Retinal fundus photograph. 45° field of view
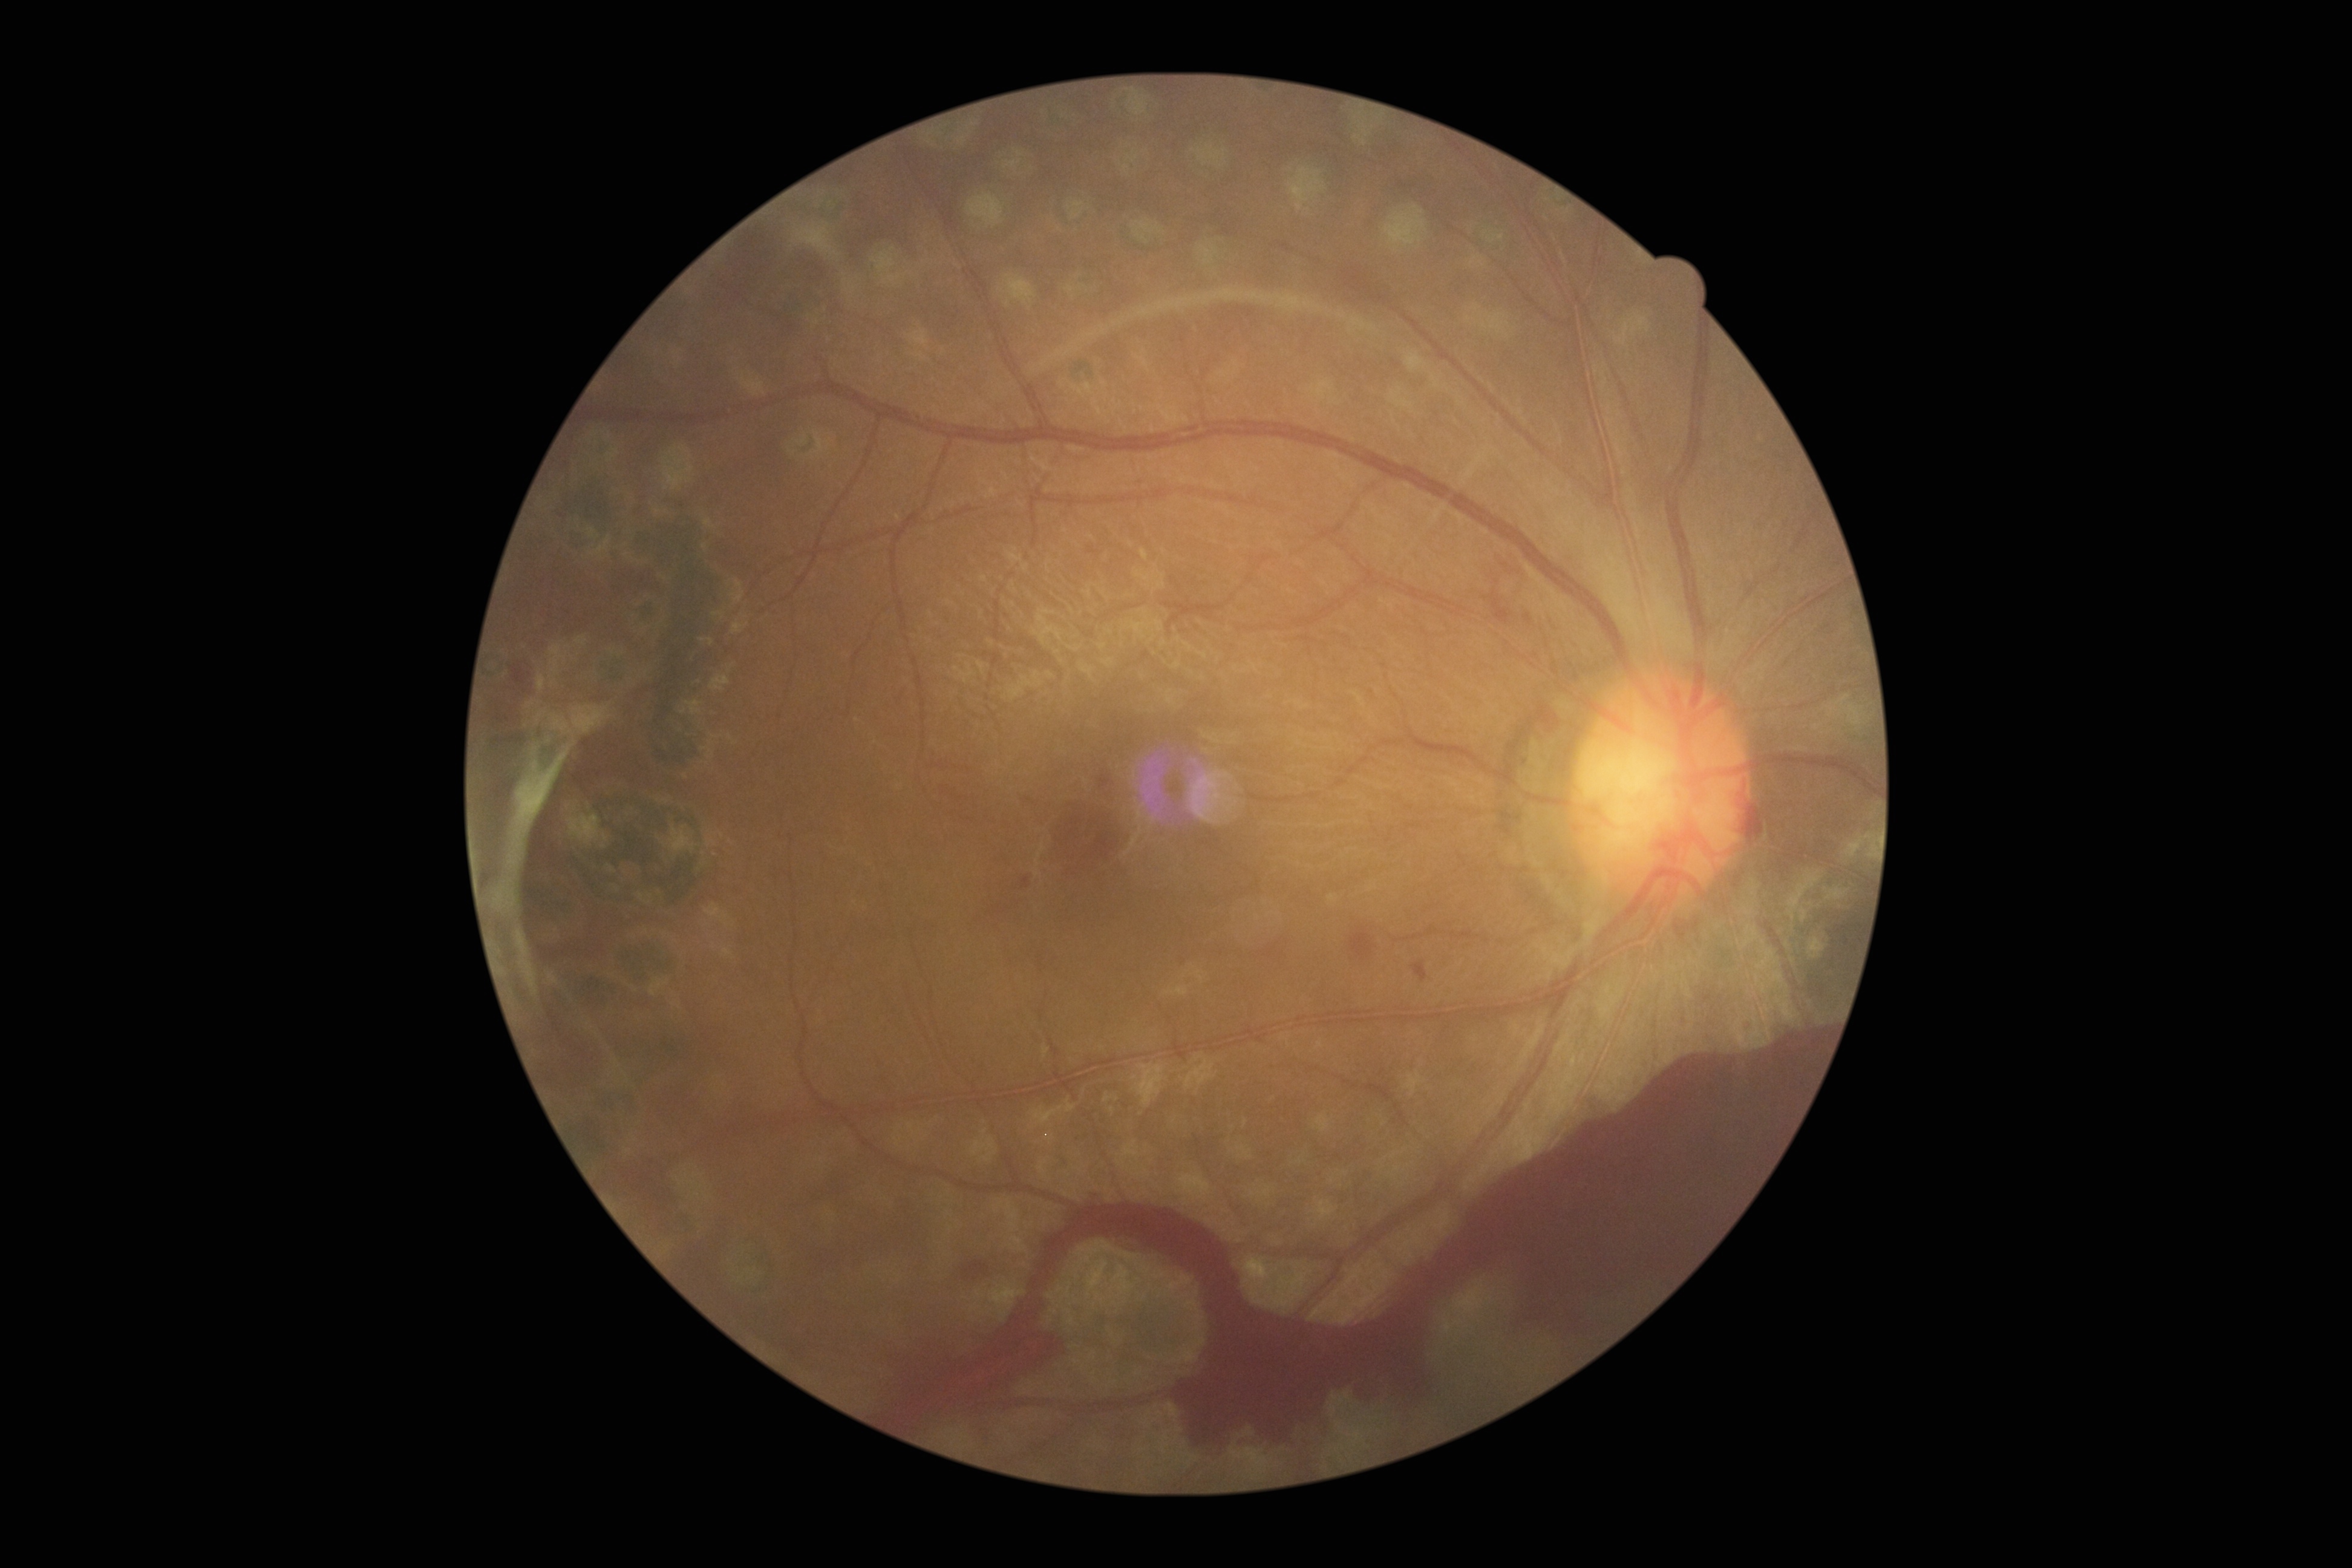
DR: 4.